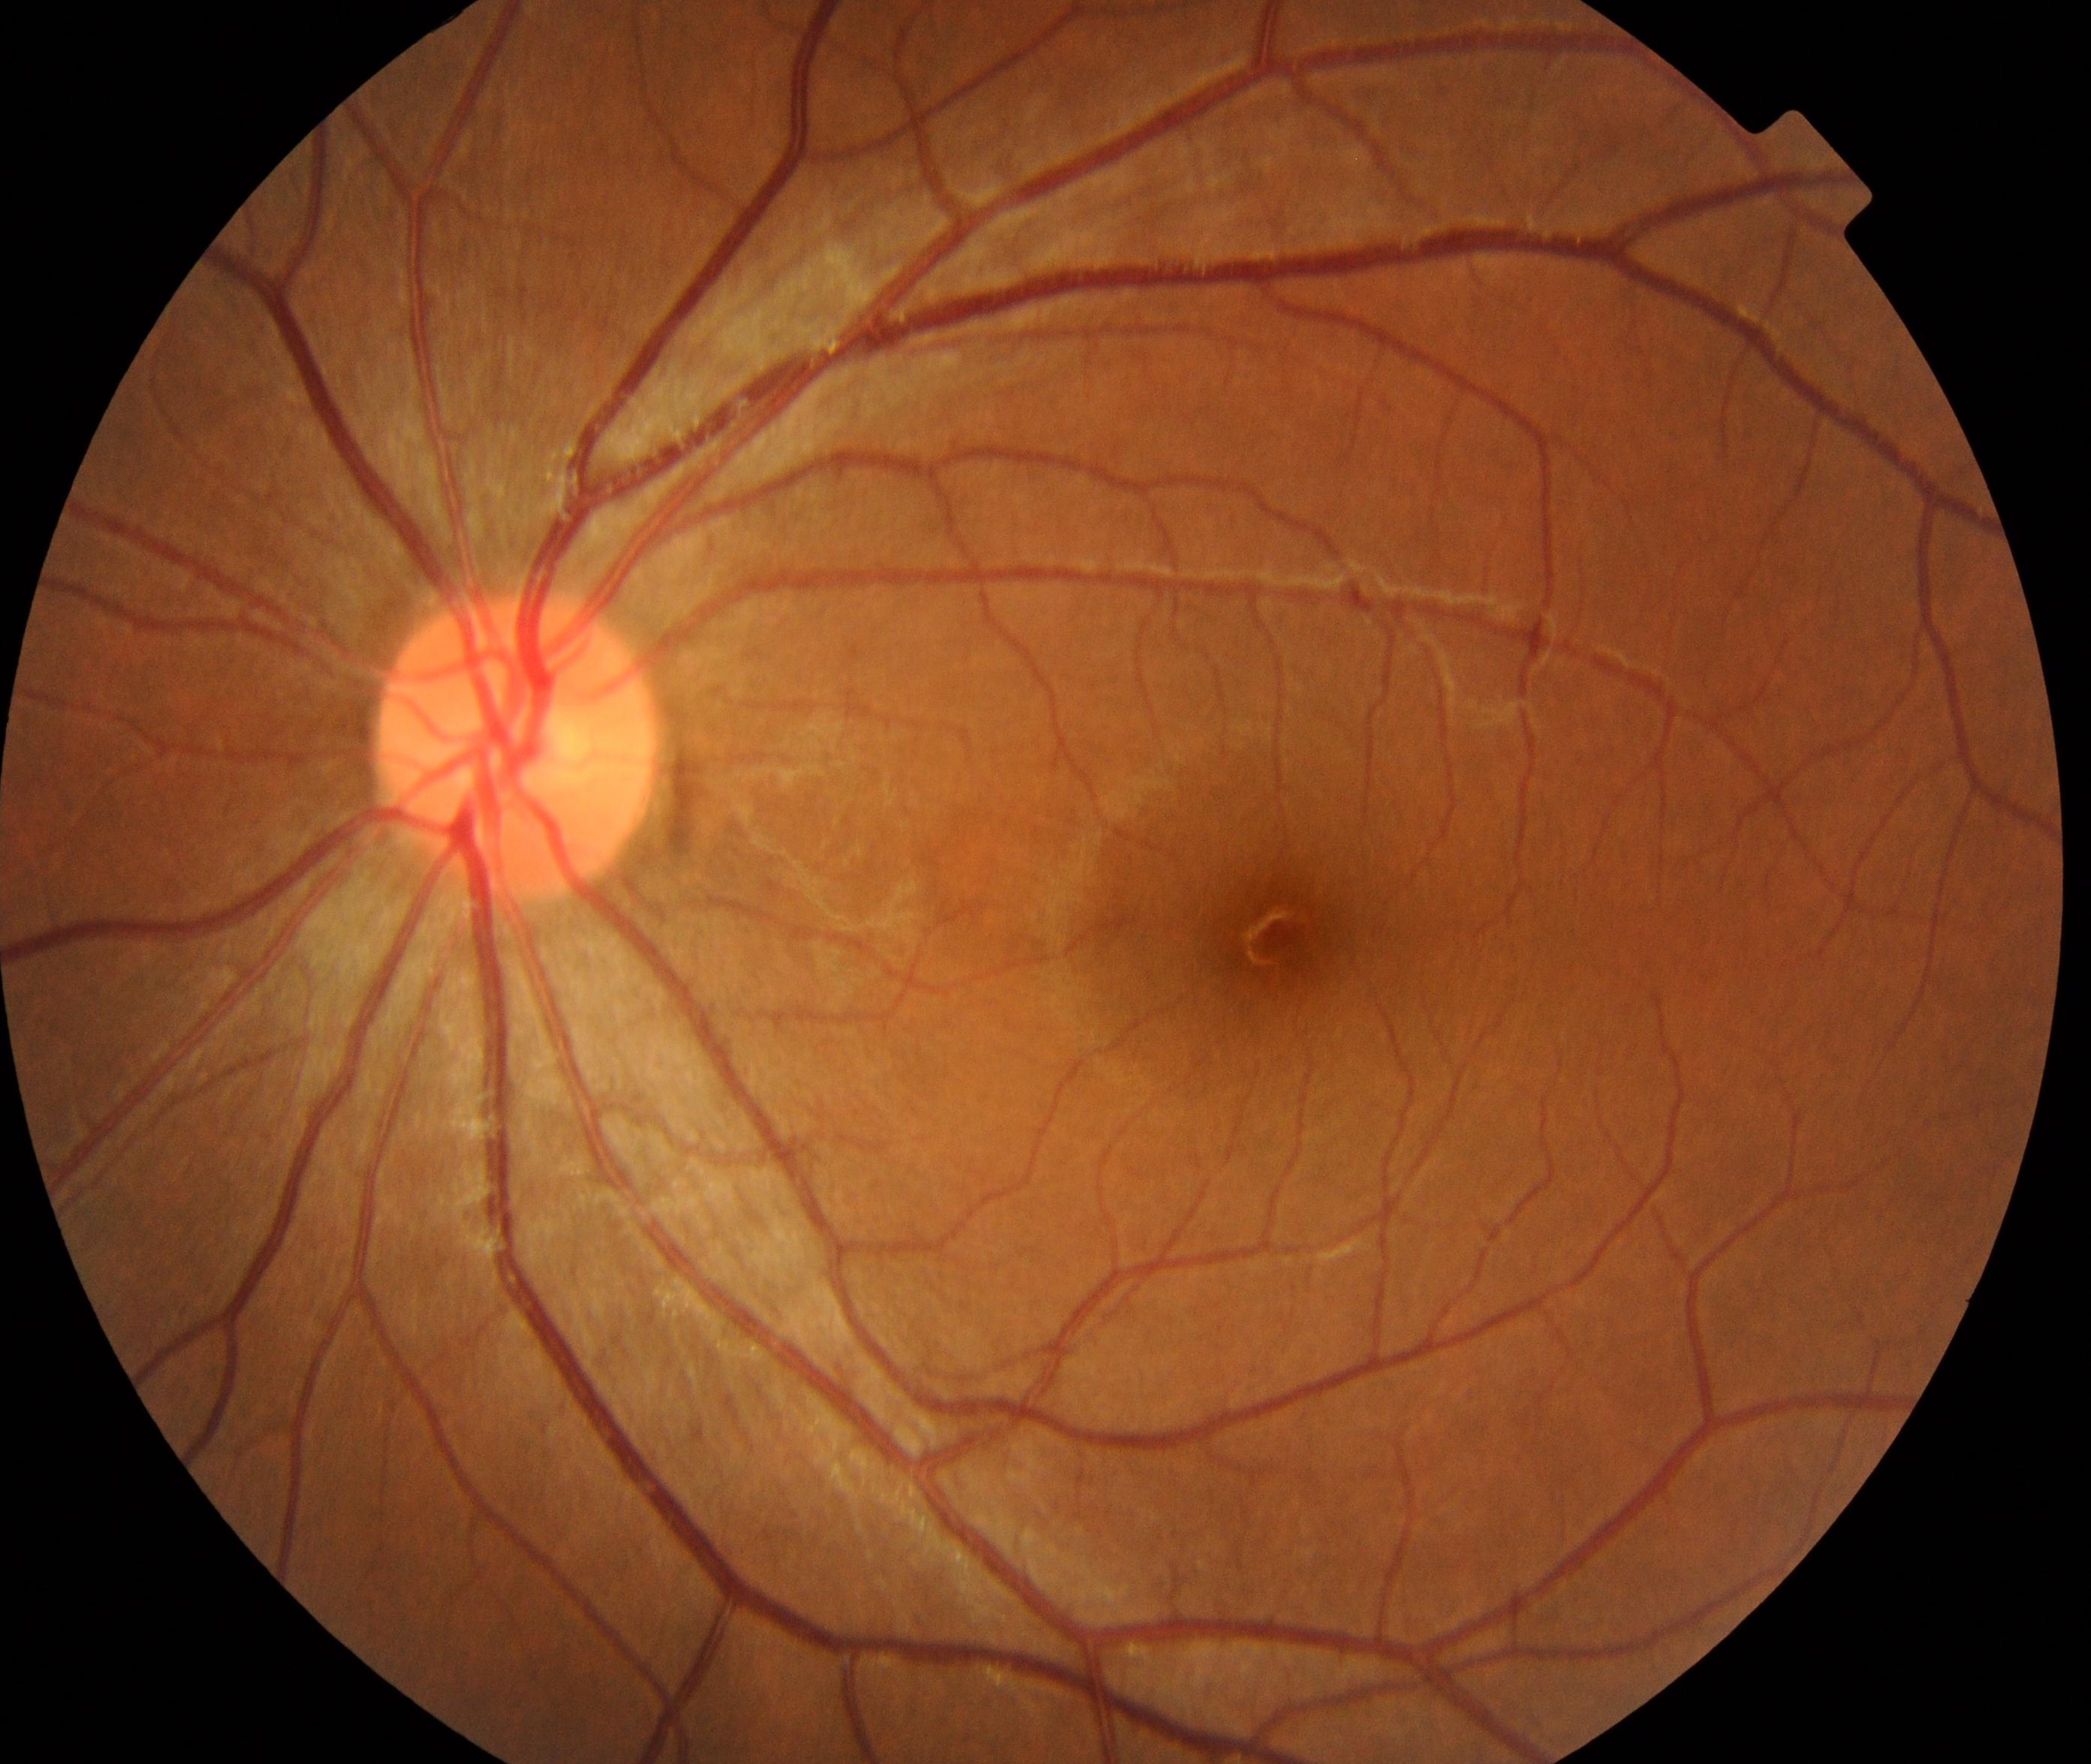 Impression: within normal limits.